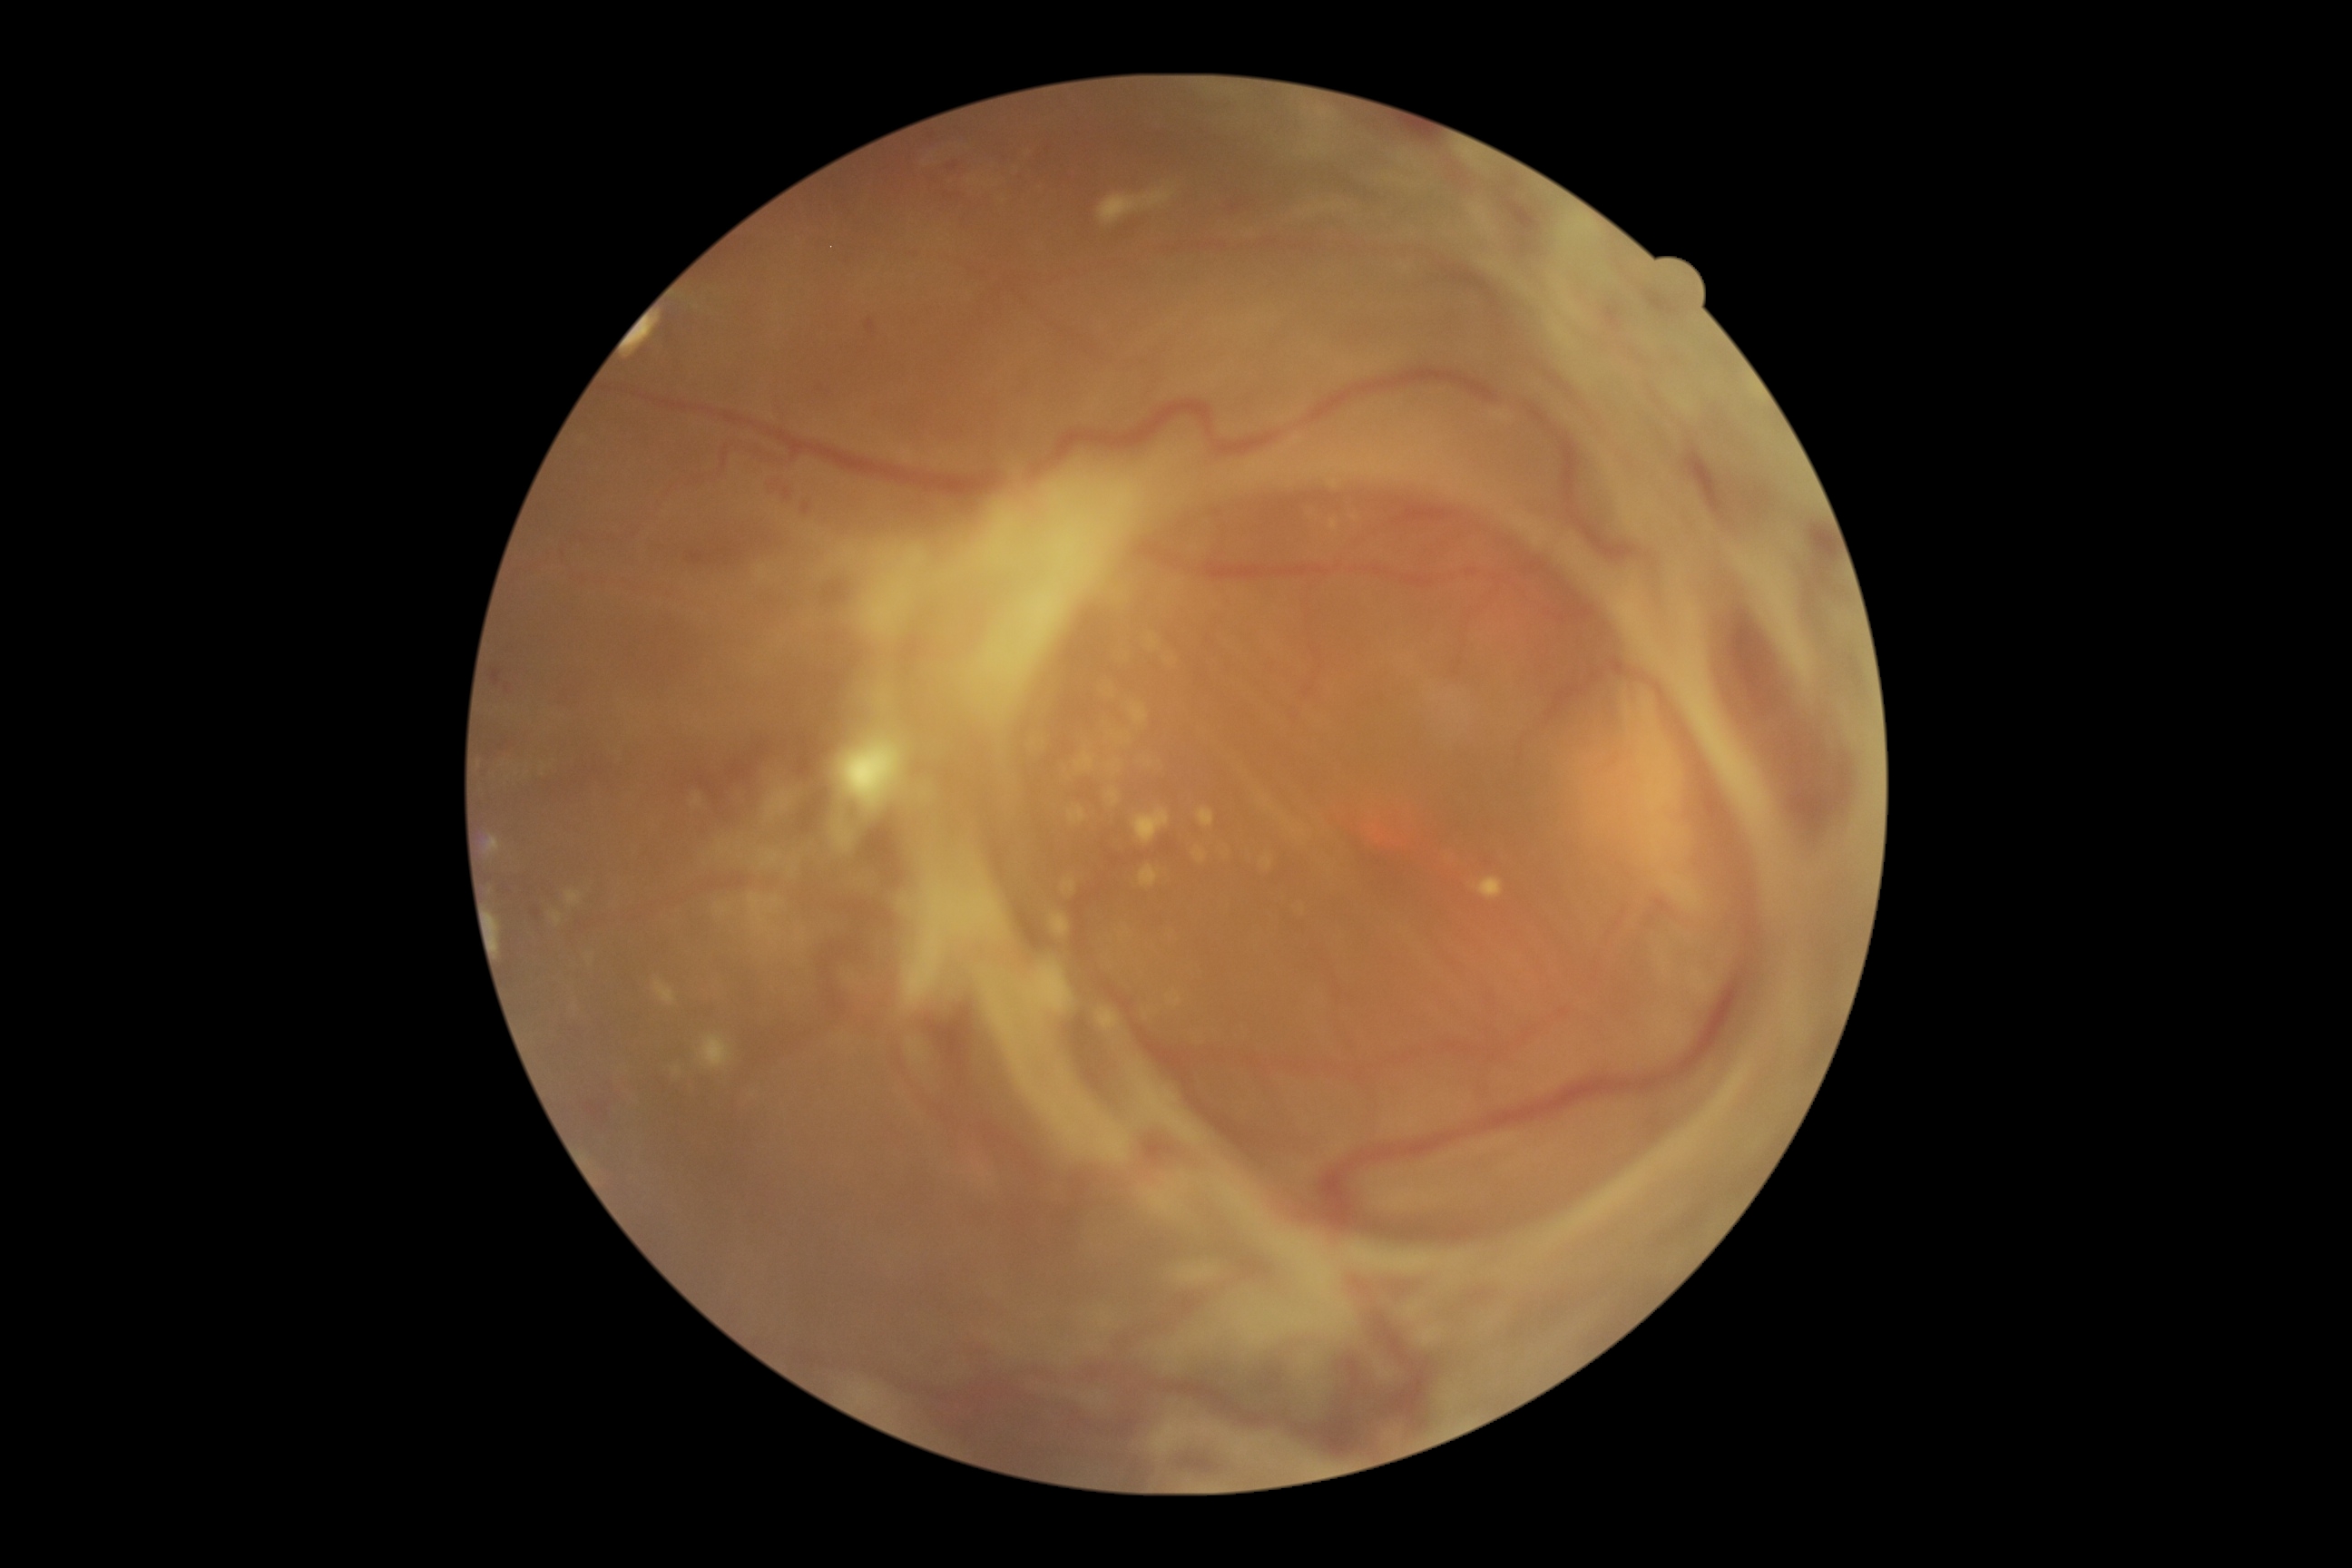

retinopathy = proliferative diabetic retinopathy (grade 4).